Image size 848x848. Modified Davis classification:
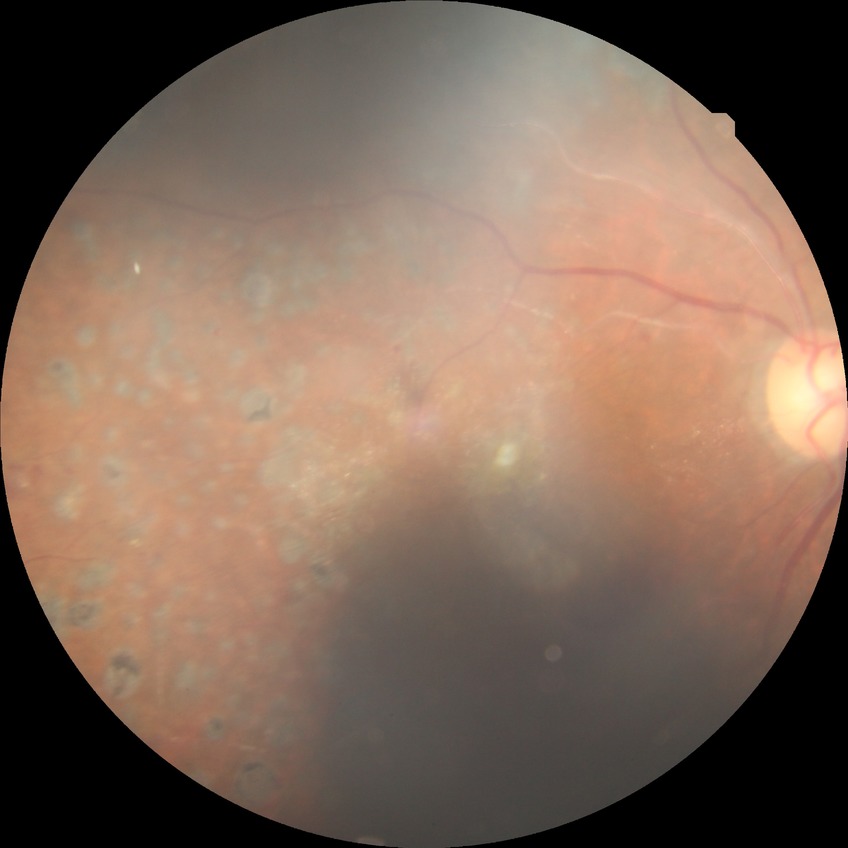

diabetic retinopathy grade=proliferative diabetic retinopathy.